Acquired with a NIDEK AFC-230 · image size 848x848 · no pharmacologic dilation · graded on the modified Davis scale
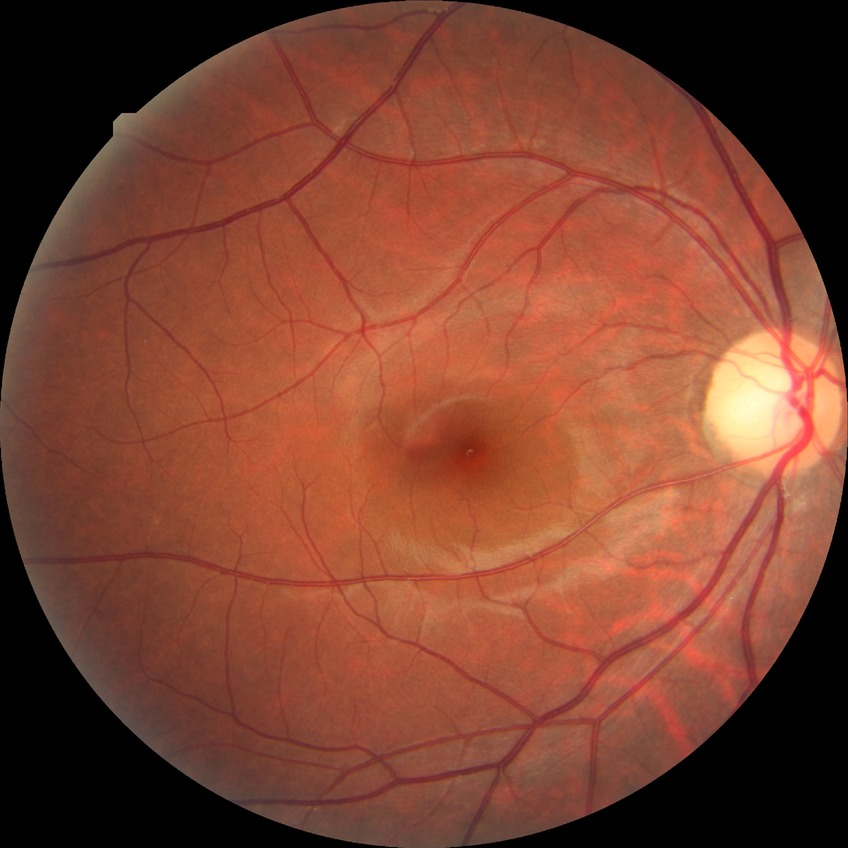
Diabetic retinopathy (DR): no diabetic retinopathy (NDR).